Infant wide-field fundus photograph; camera: Natus RetCam Envision (130° FOV); 1440 by 1080 pixels.
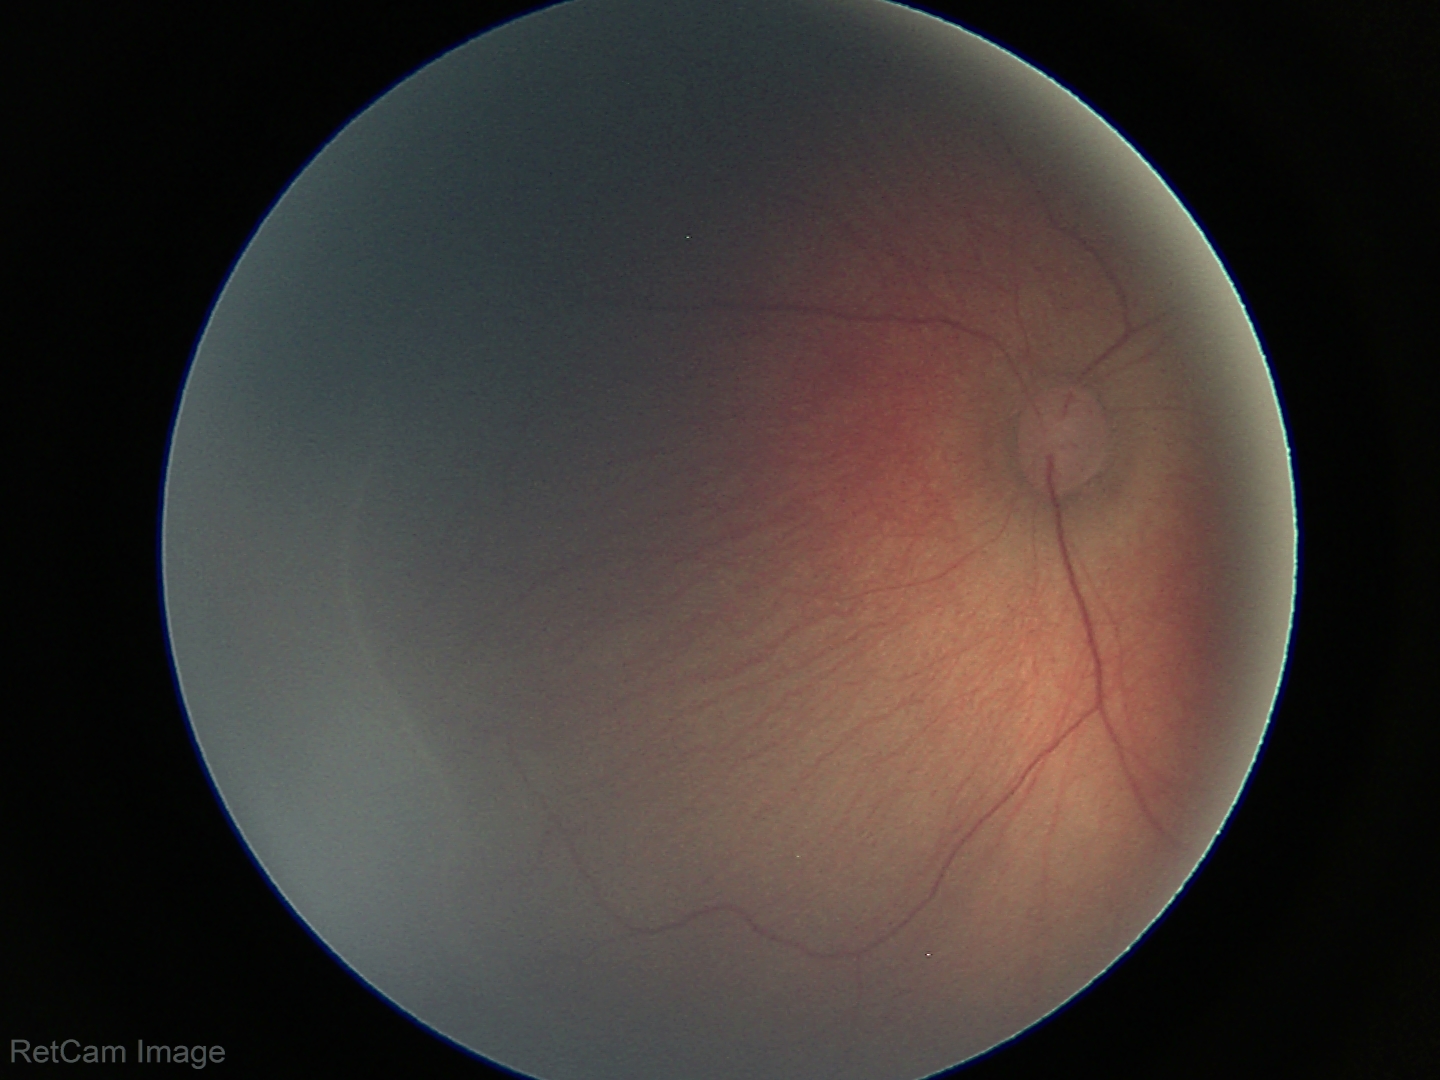

Impression: no plus disease; ROP stage 1.